45-degree field of view, camera: NIDEK AFC-230, nonmydriatic, image size 848x848, graded on the modified Davis scale
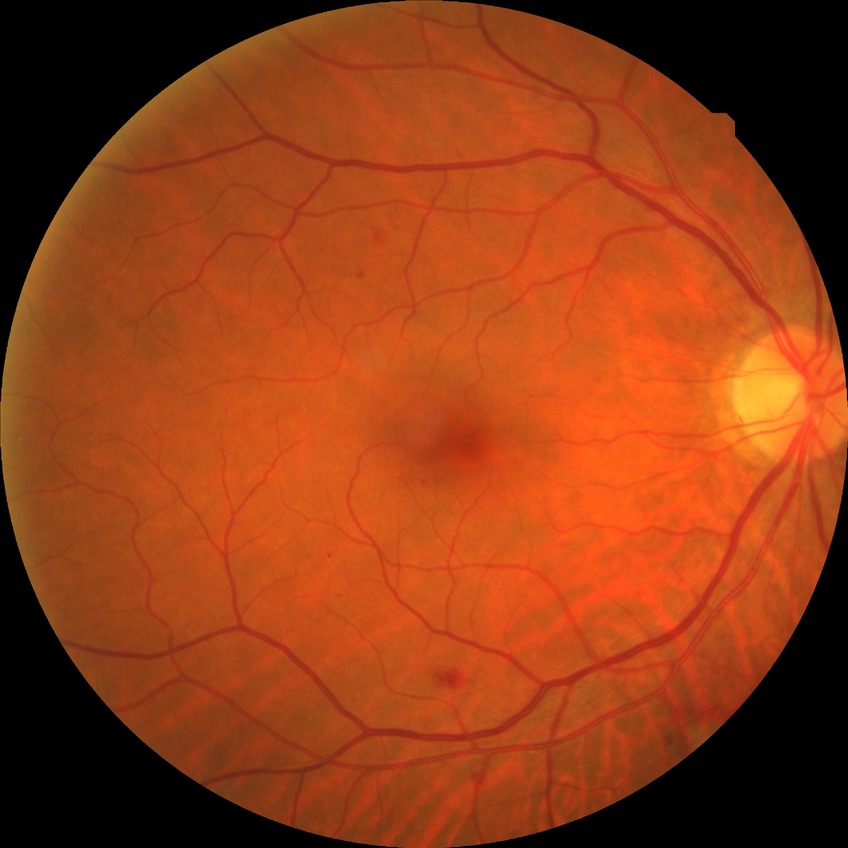

The retinopathy is classified as non-proliferative diabetic retinopathy. Diabetic retinopathy (DR): simple diabetic retinopathy (SDR).